2184 x 1690 pixels
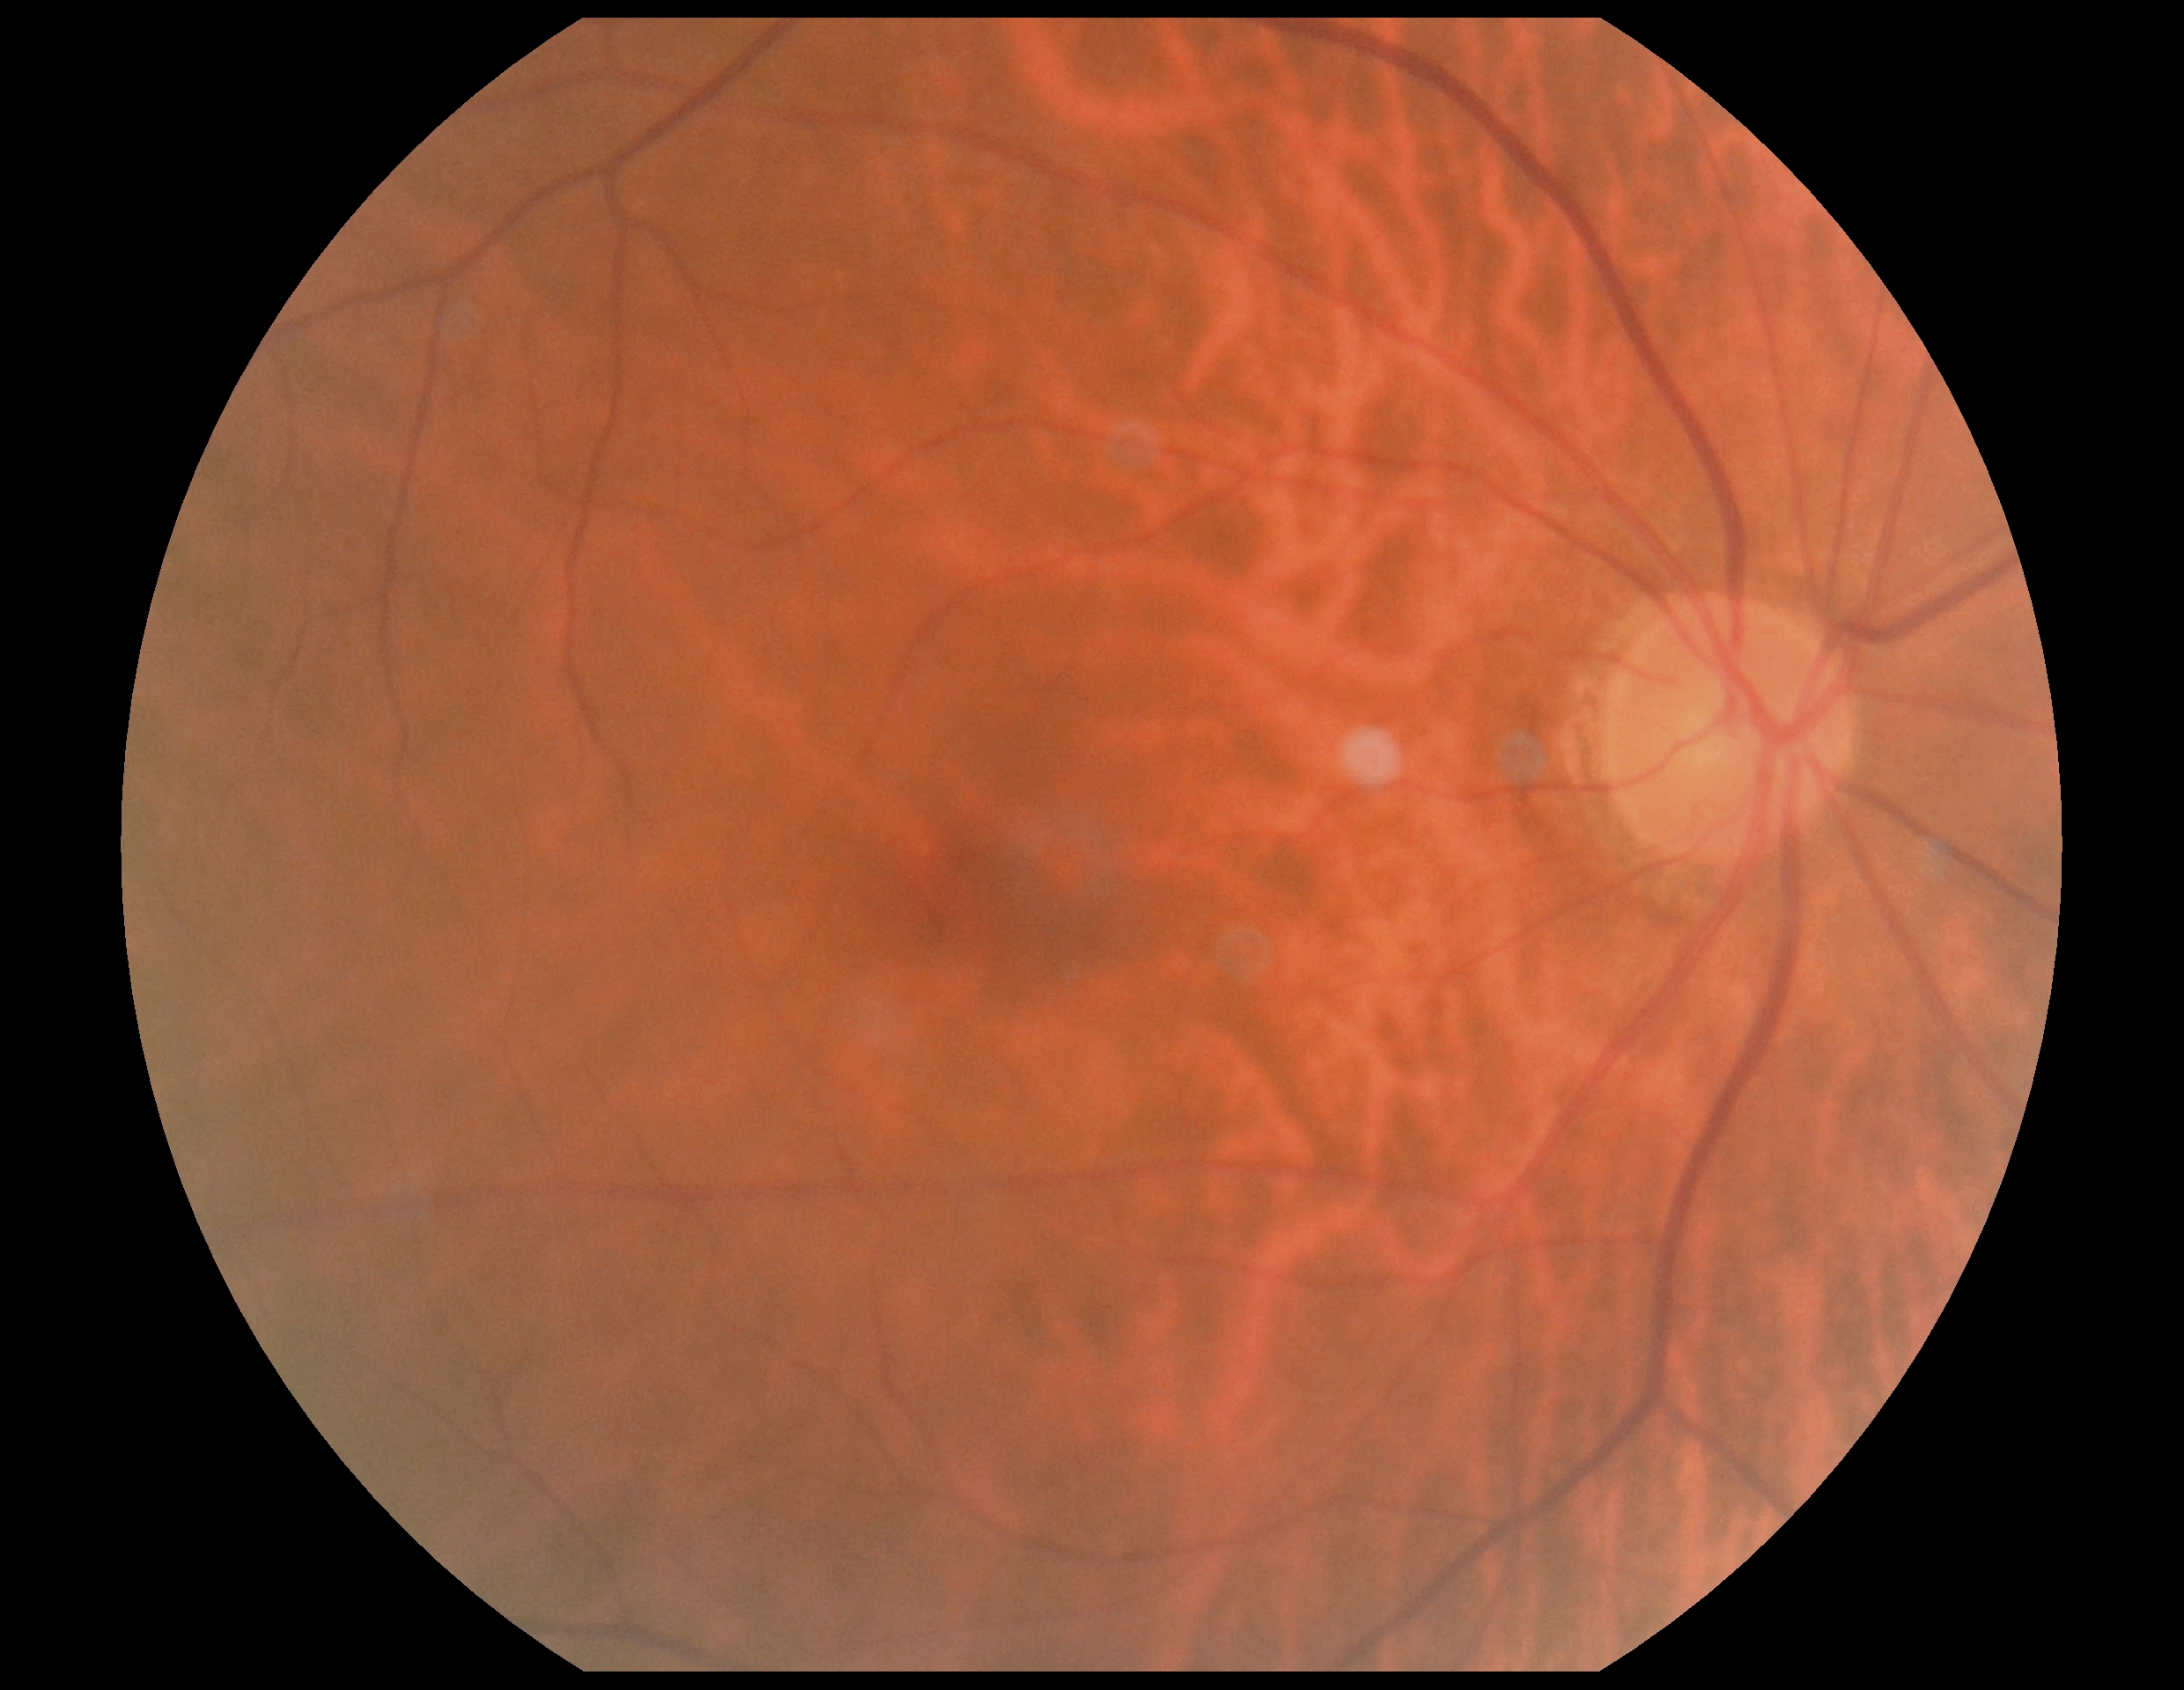 diabetic retinopathy grade = 0/4.